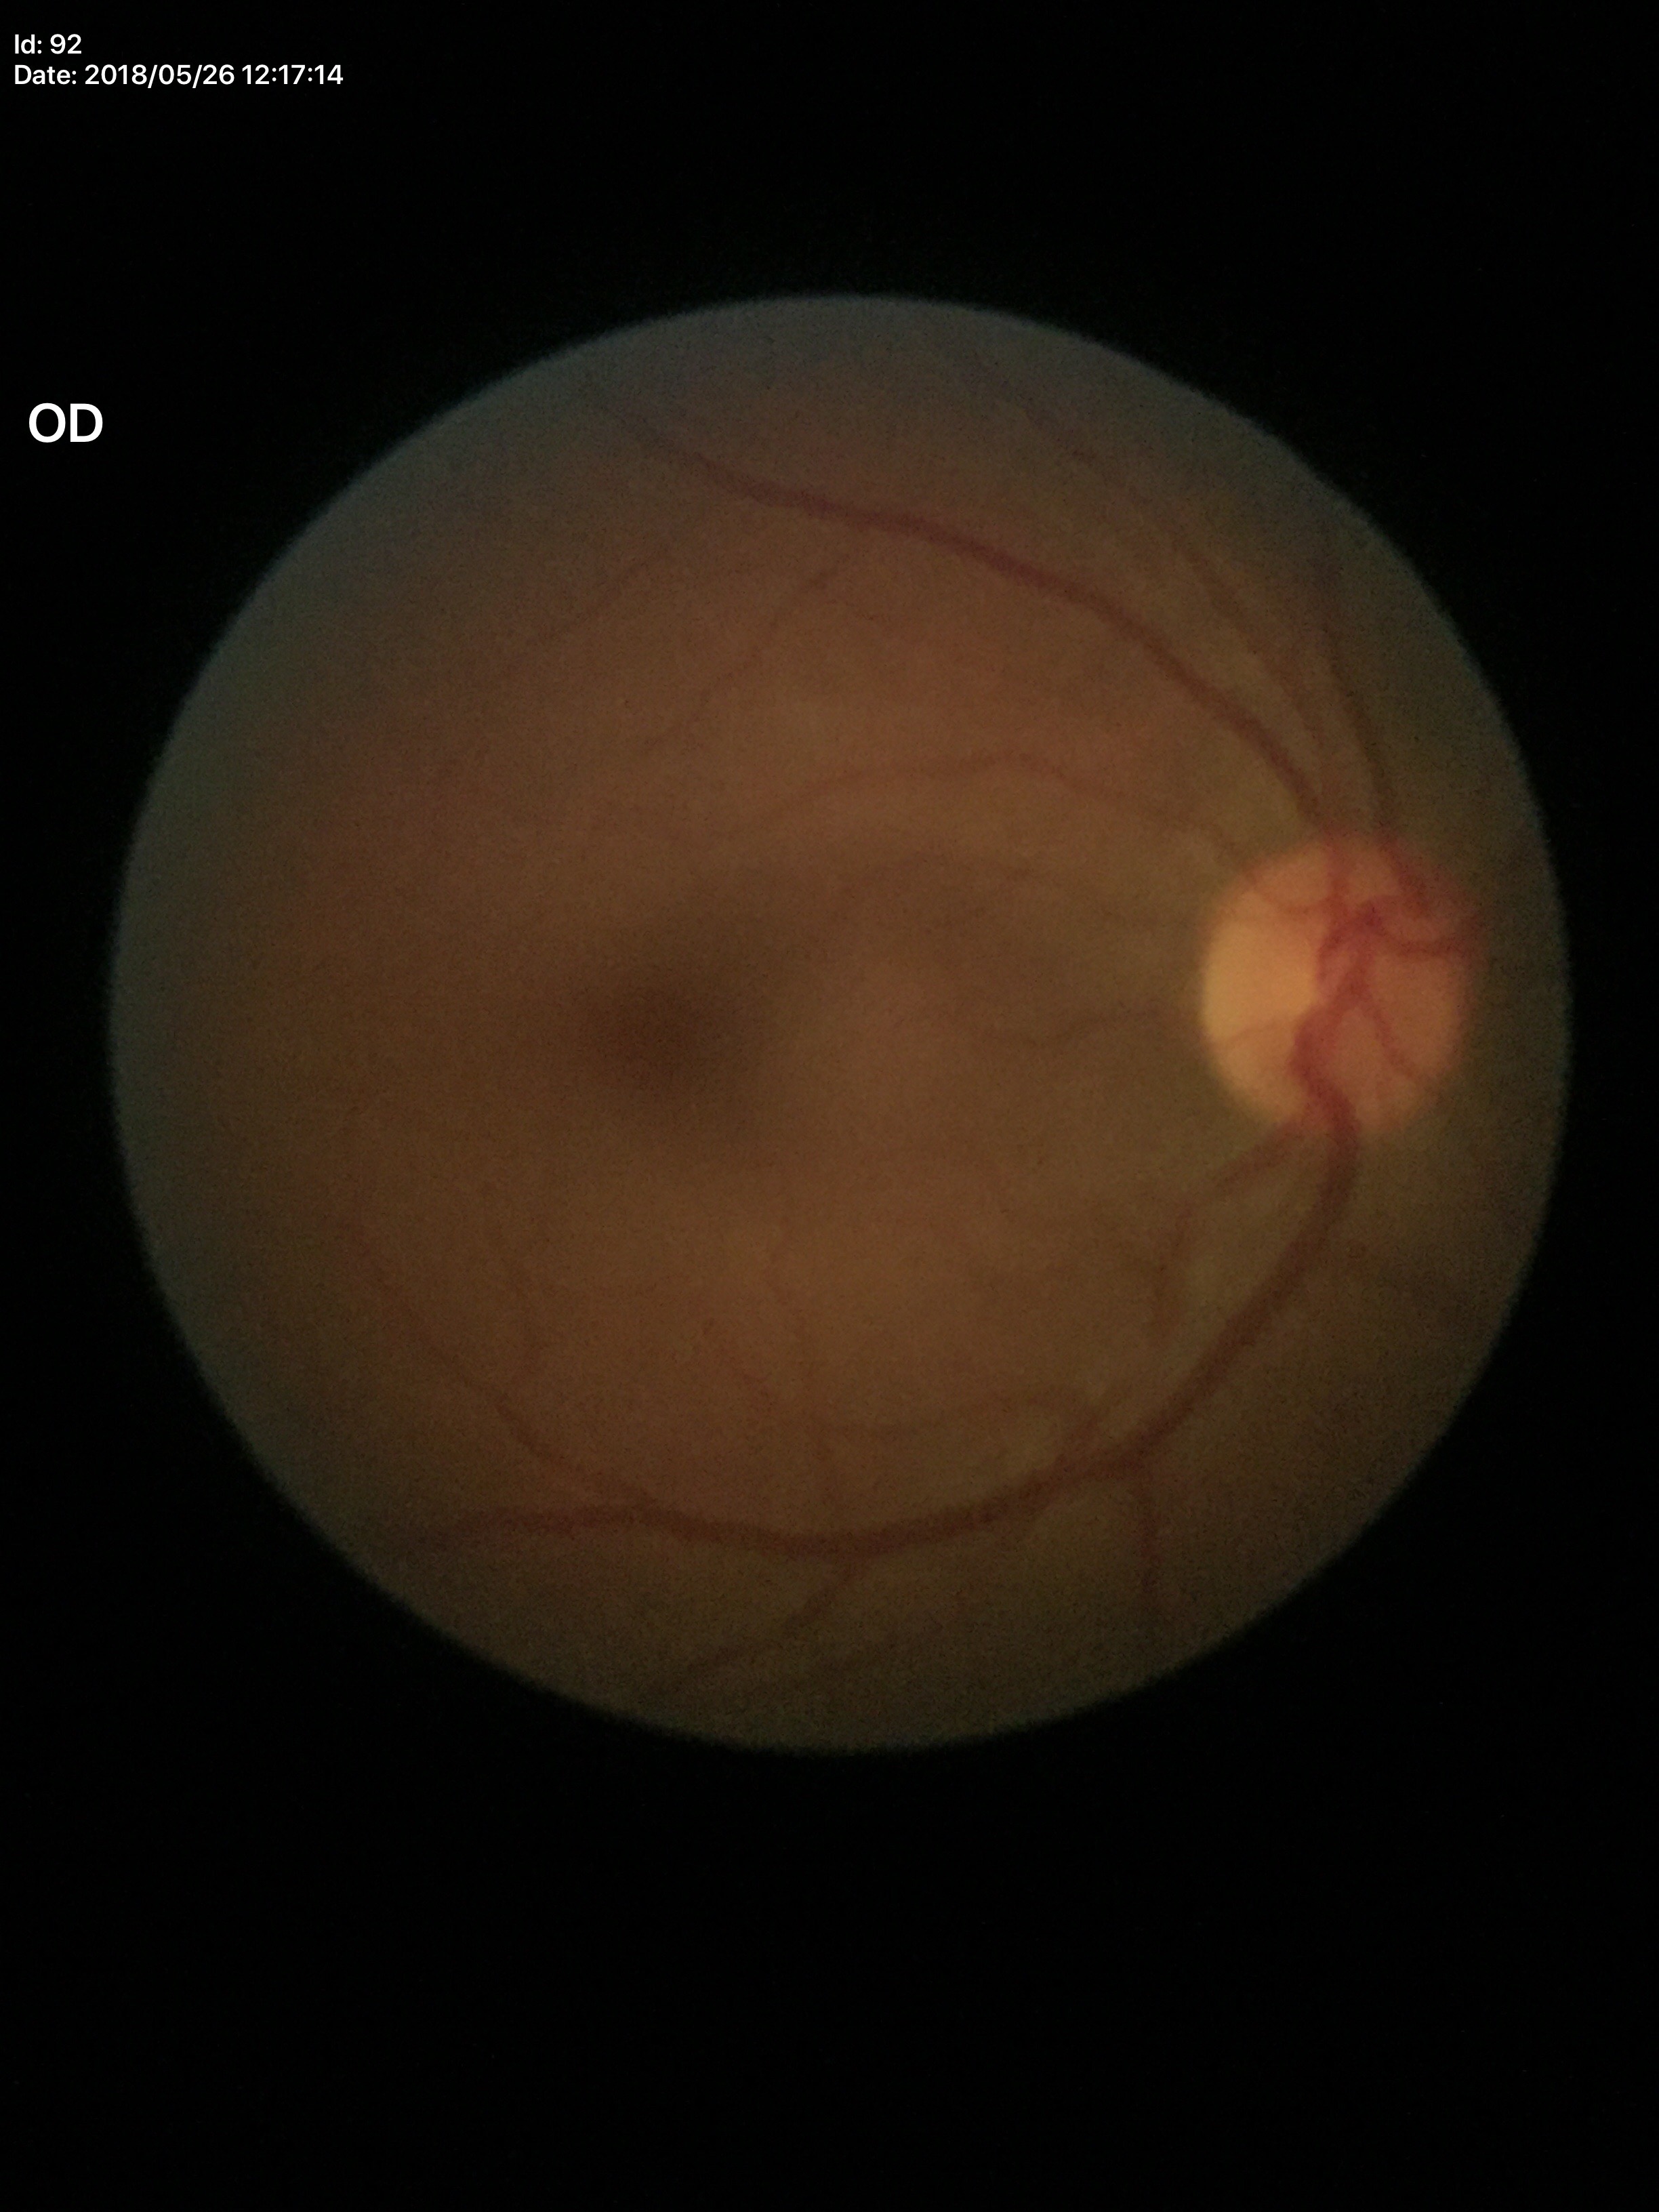 Horizontal cup-disc ratio (HCDR): 0.47.
Glaucoma decision: no suspicious findings.
Vertical cup-disc ratio (VCDR) is 0.46.